CFP; 848 by 848 pixels; nonmydriatic; NIDEK AFC-230.
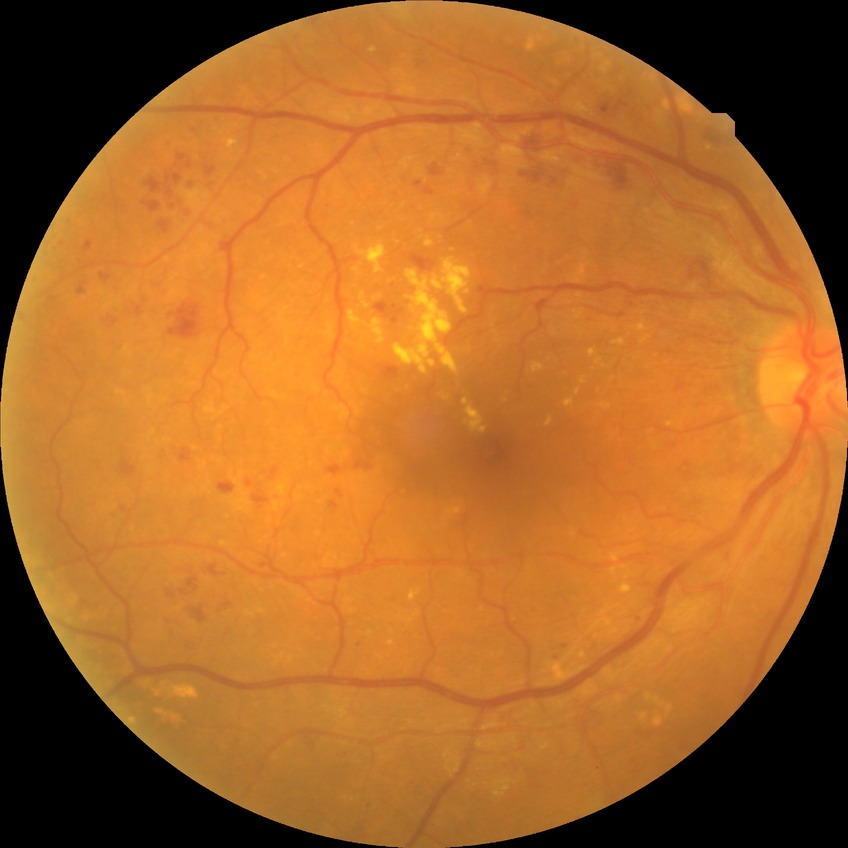
davis_grade: proliferative diabetic retinopathy